Retinal fundus photograph: 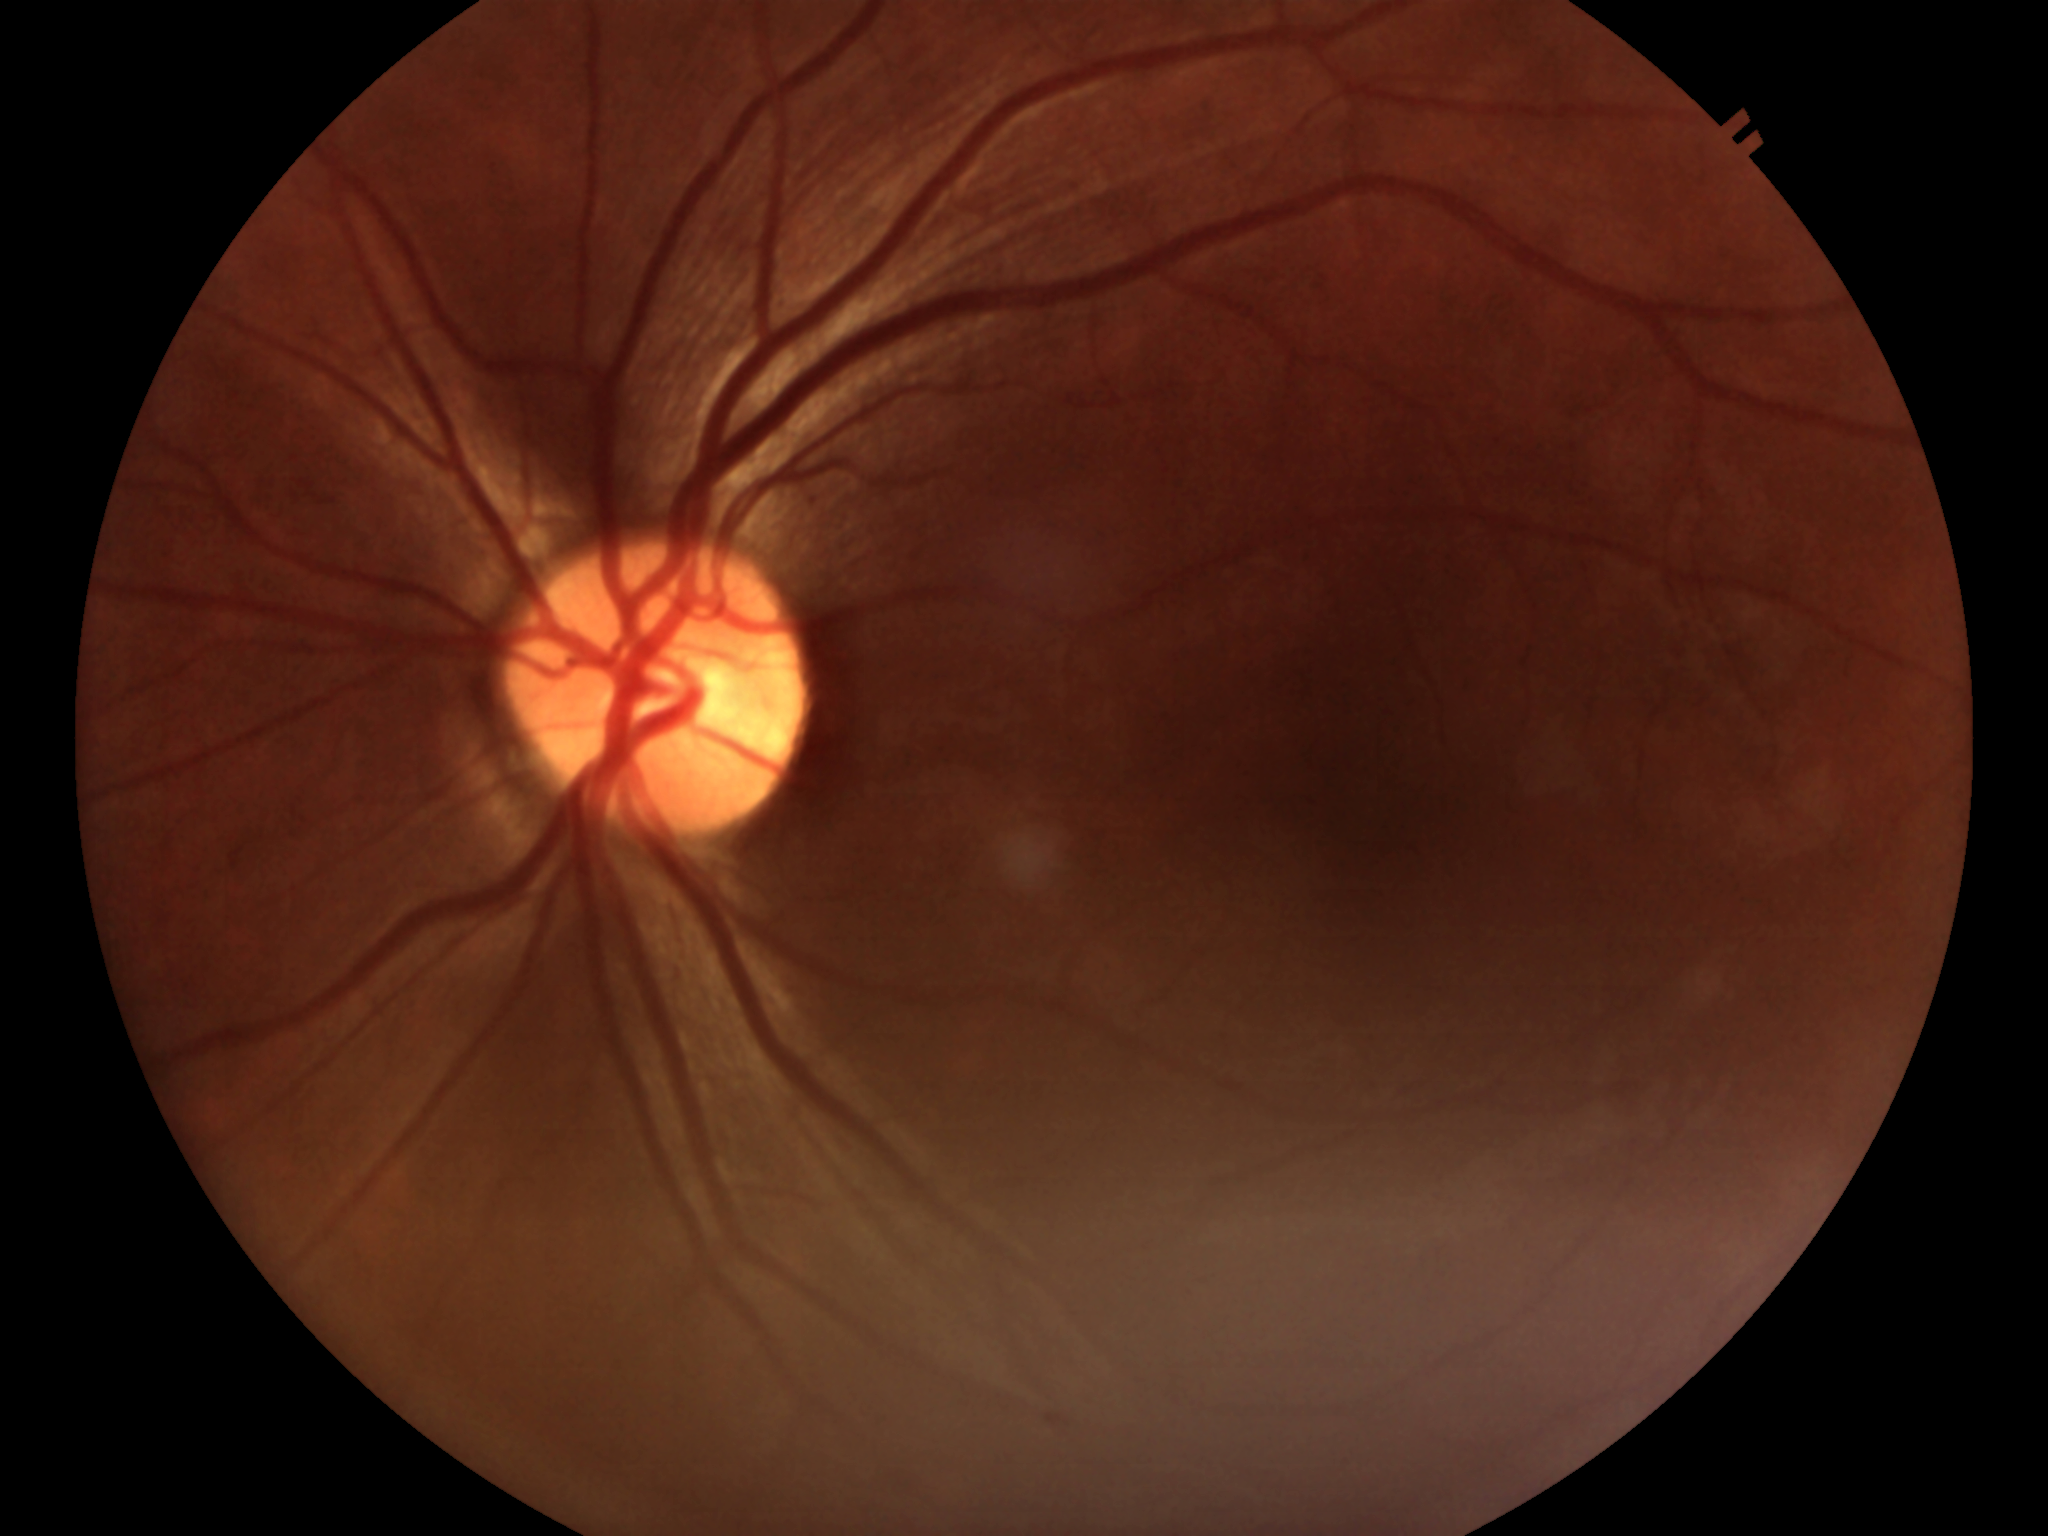
No evidence of glaucoma (5/5 ophthalmologists in agreement).
Vertical CDR: 0.44.